FOV: 45 degrees. Fundus photo. Davis DR grading — 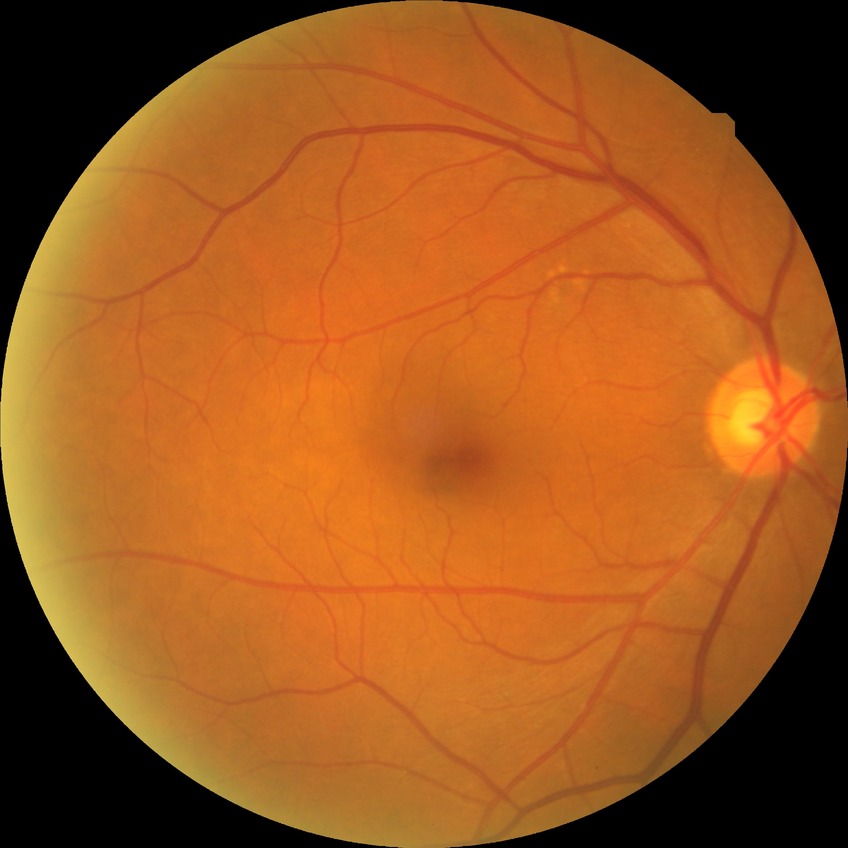

Diabetic retinopathy (DR) is no diabetic retinopathy (NDR).